1380 x 1382 pixels — 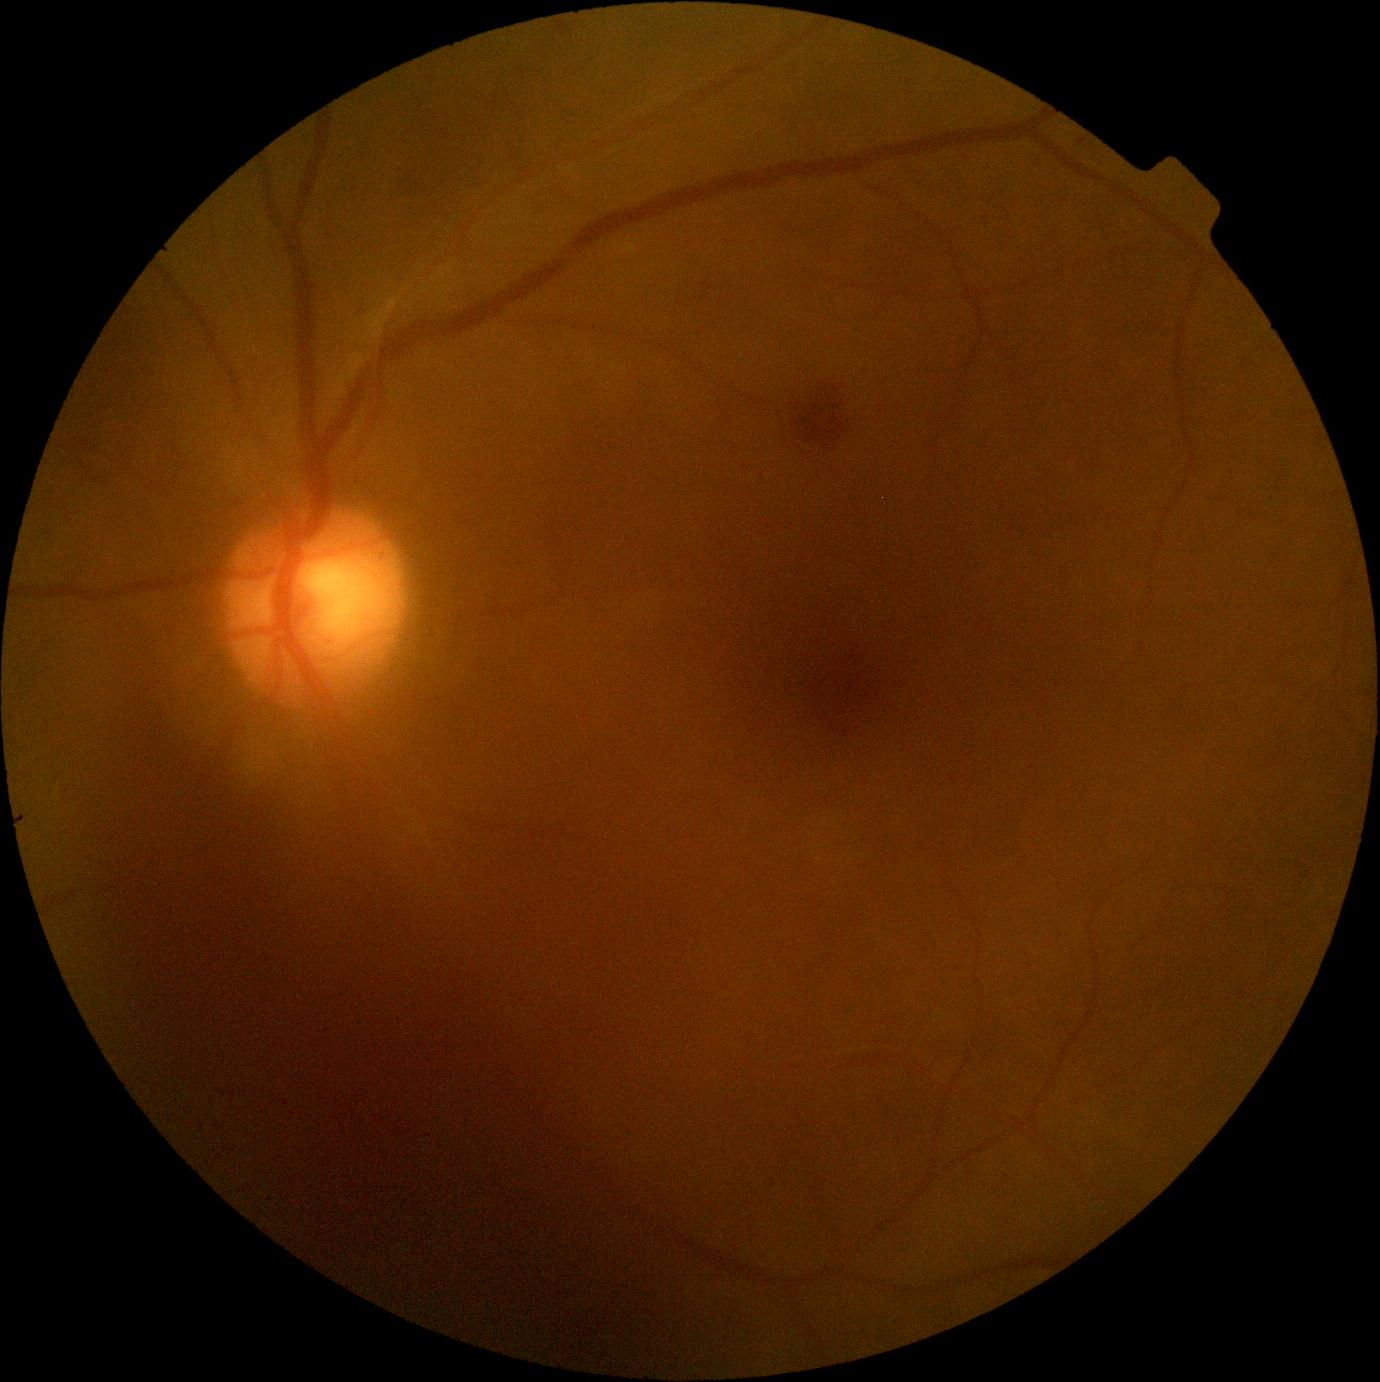
dr_grade: 4
dr_grade_name: PDR
lesions:
  he:
    - left=87, top=676, right=749, bottom=1373
    - left=796, top=375, right=845, bottom=451
  se: []
  ex: []
  ma: []